512 by 512 pixels.
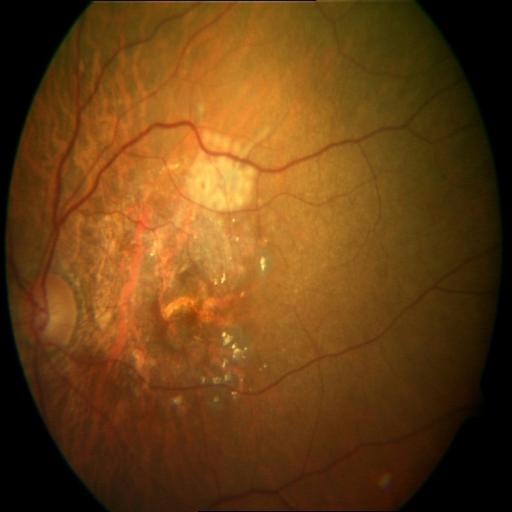

Diagnoses:
- MYA (myopia)
- MS (macular scar)